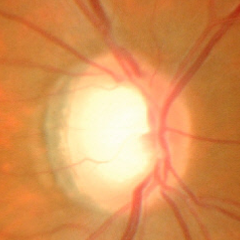

Showing no signs of glaucoma.